Ultra-widefield fundus photograph; 1924x1556; 200° field of view.
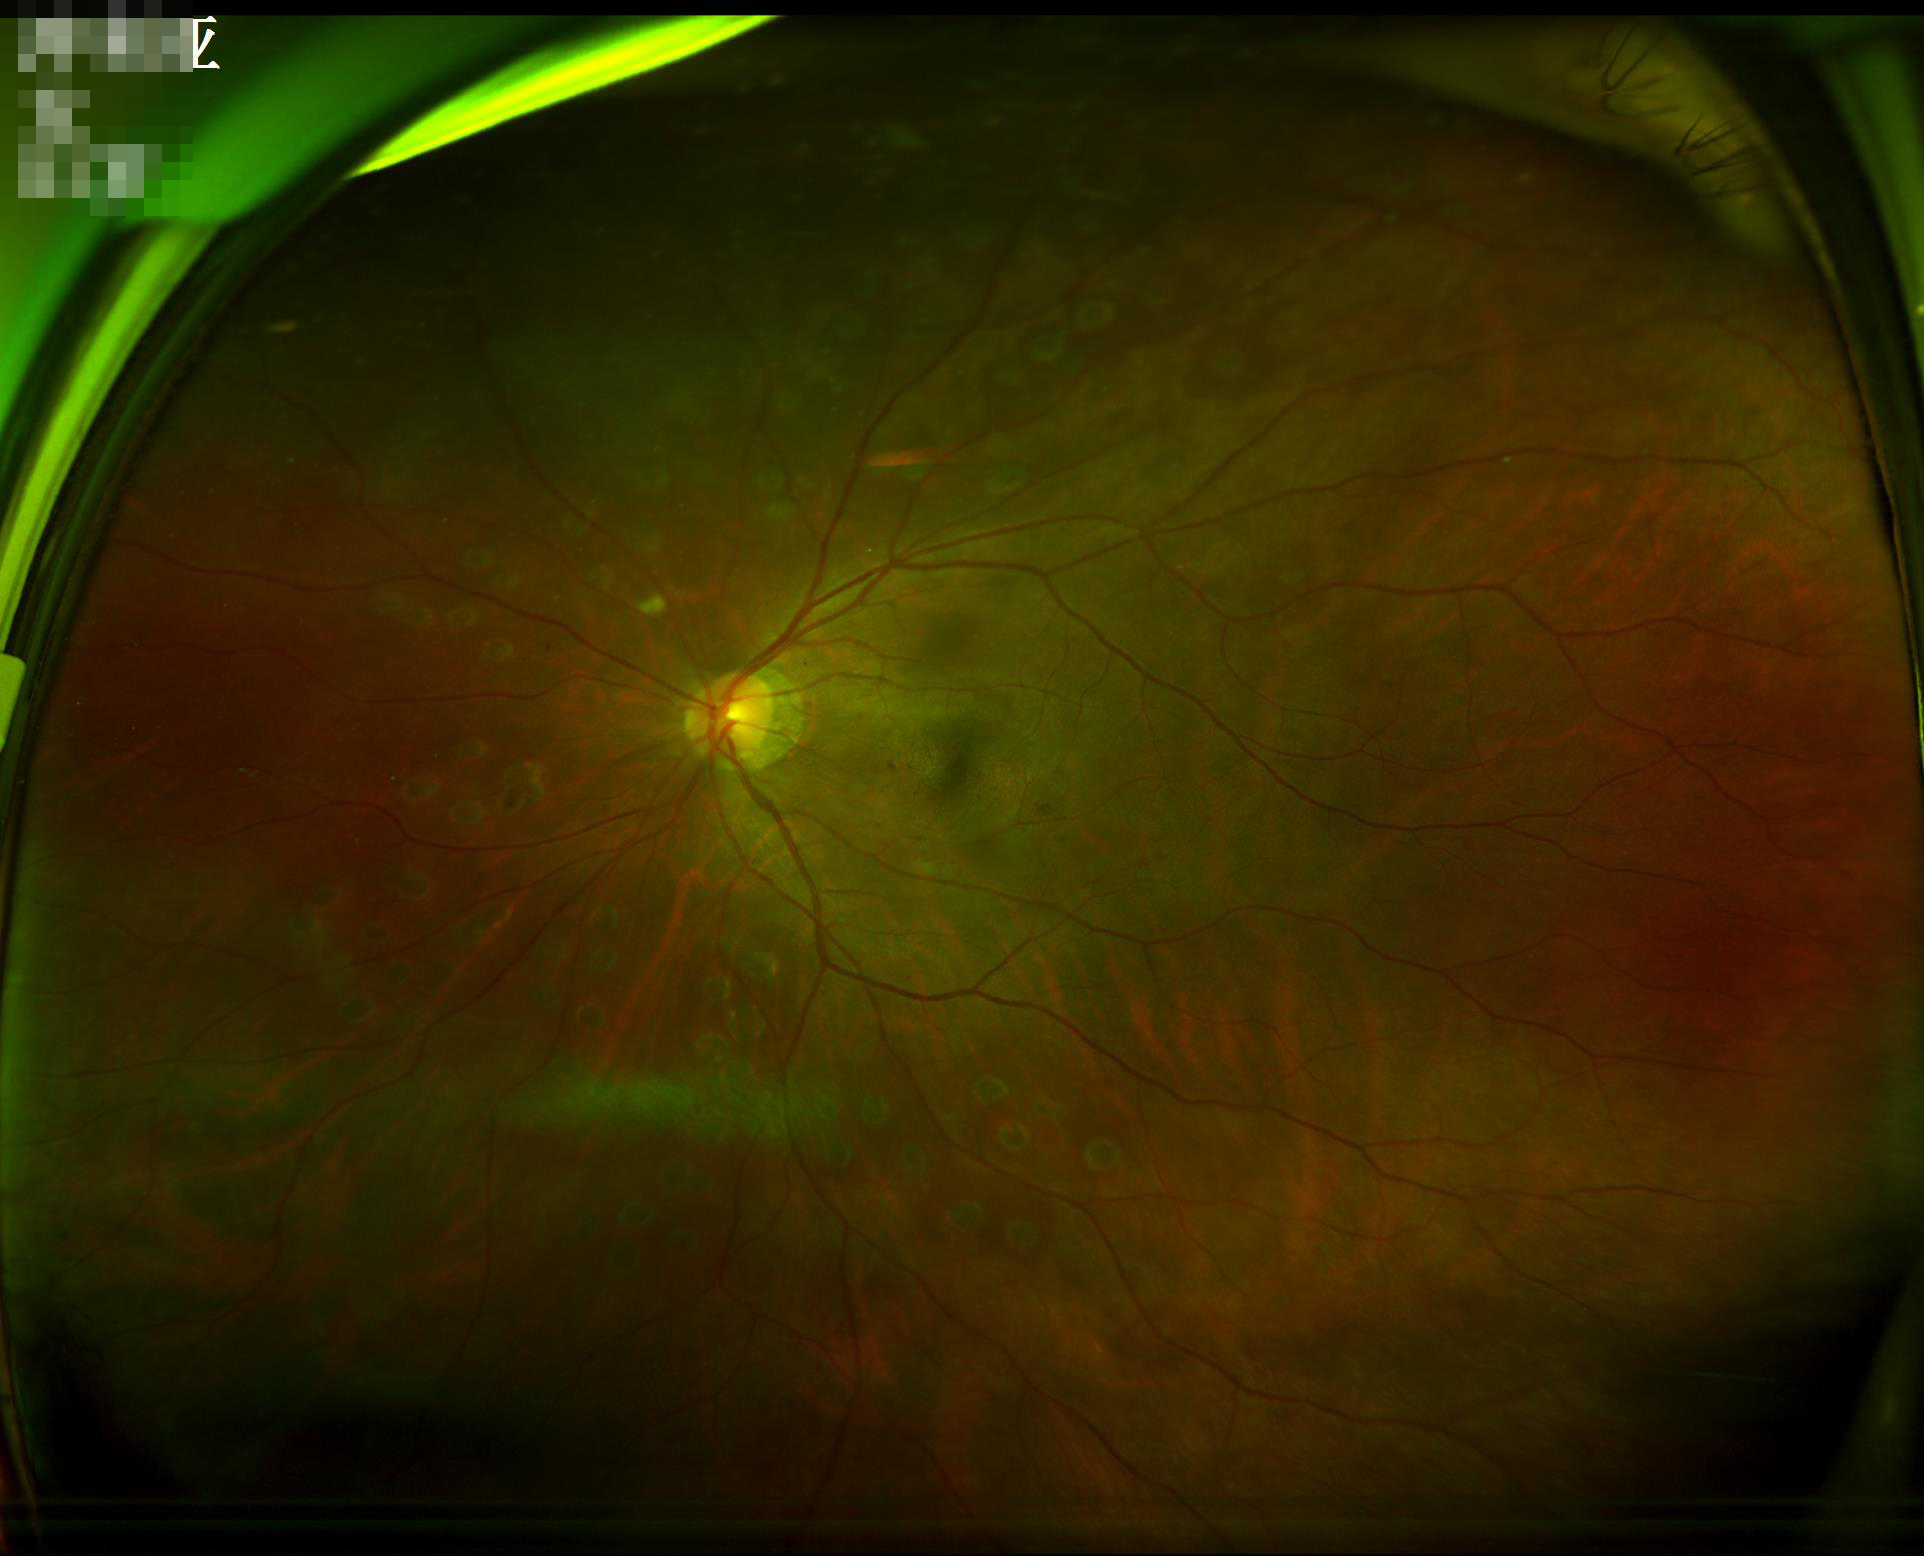

illumination: even
overall_quality: satisfactory
clarity: sharp
contrast: good